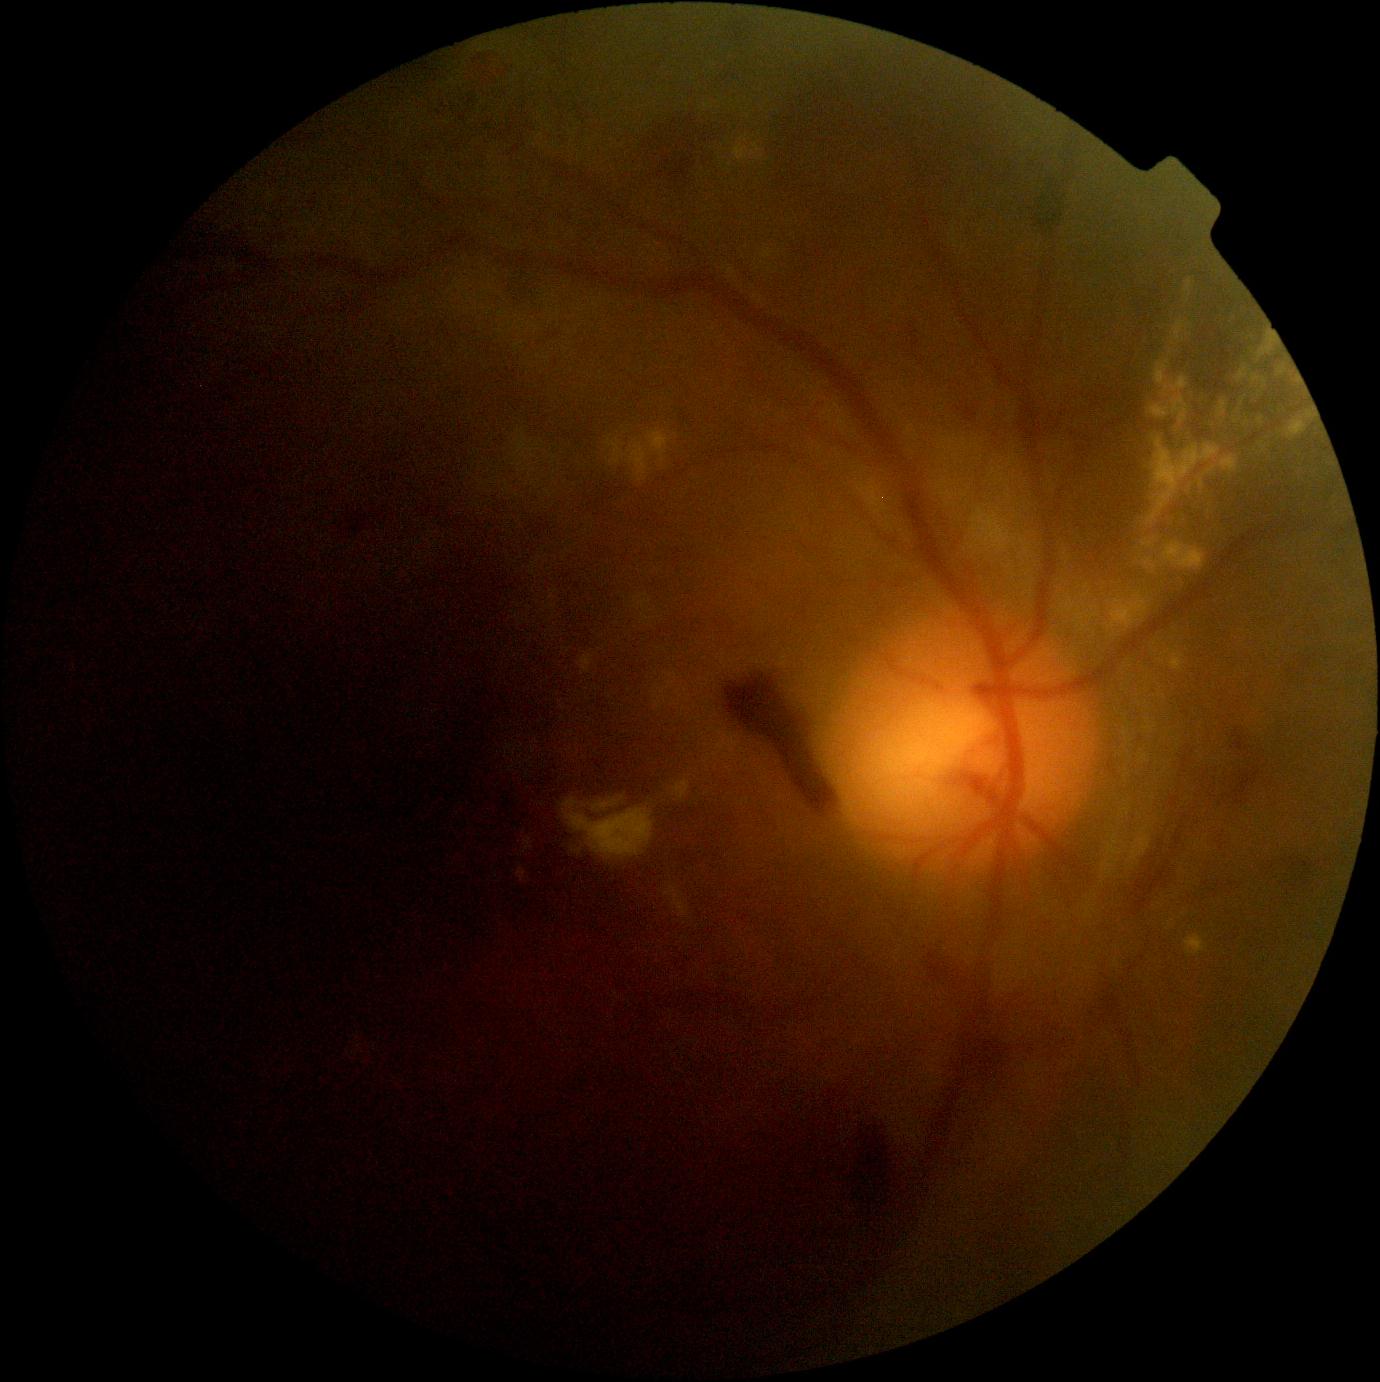
retinopathy grade: 4.